Nonmydriatic fundus photograph; 848x848; 45° FOV; graded on the modified Davis scale; color fundus image; NIDEK AFC-230 fundus camera — 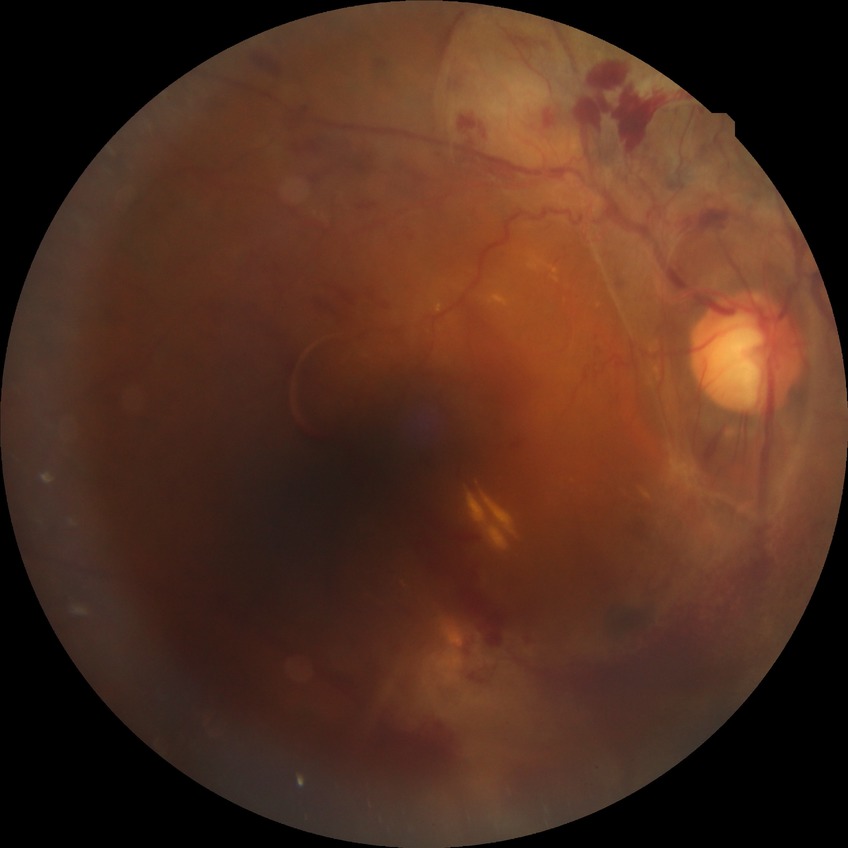

Diabetic retinopathy (DR): proliferative diabetic retinopathy (PDR).